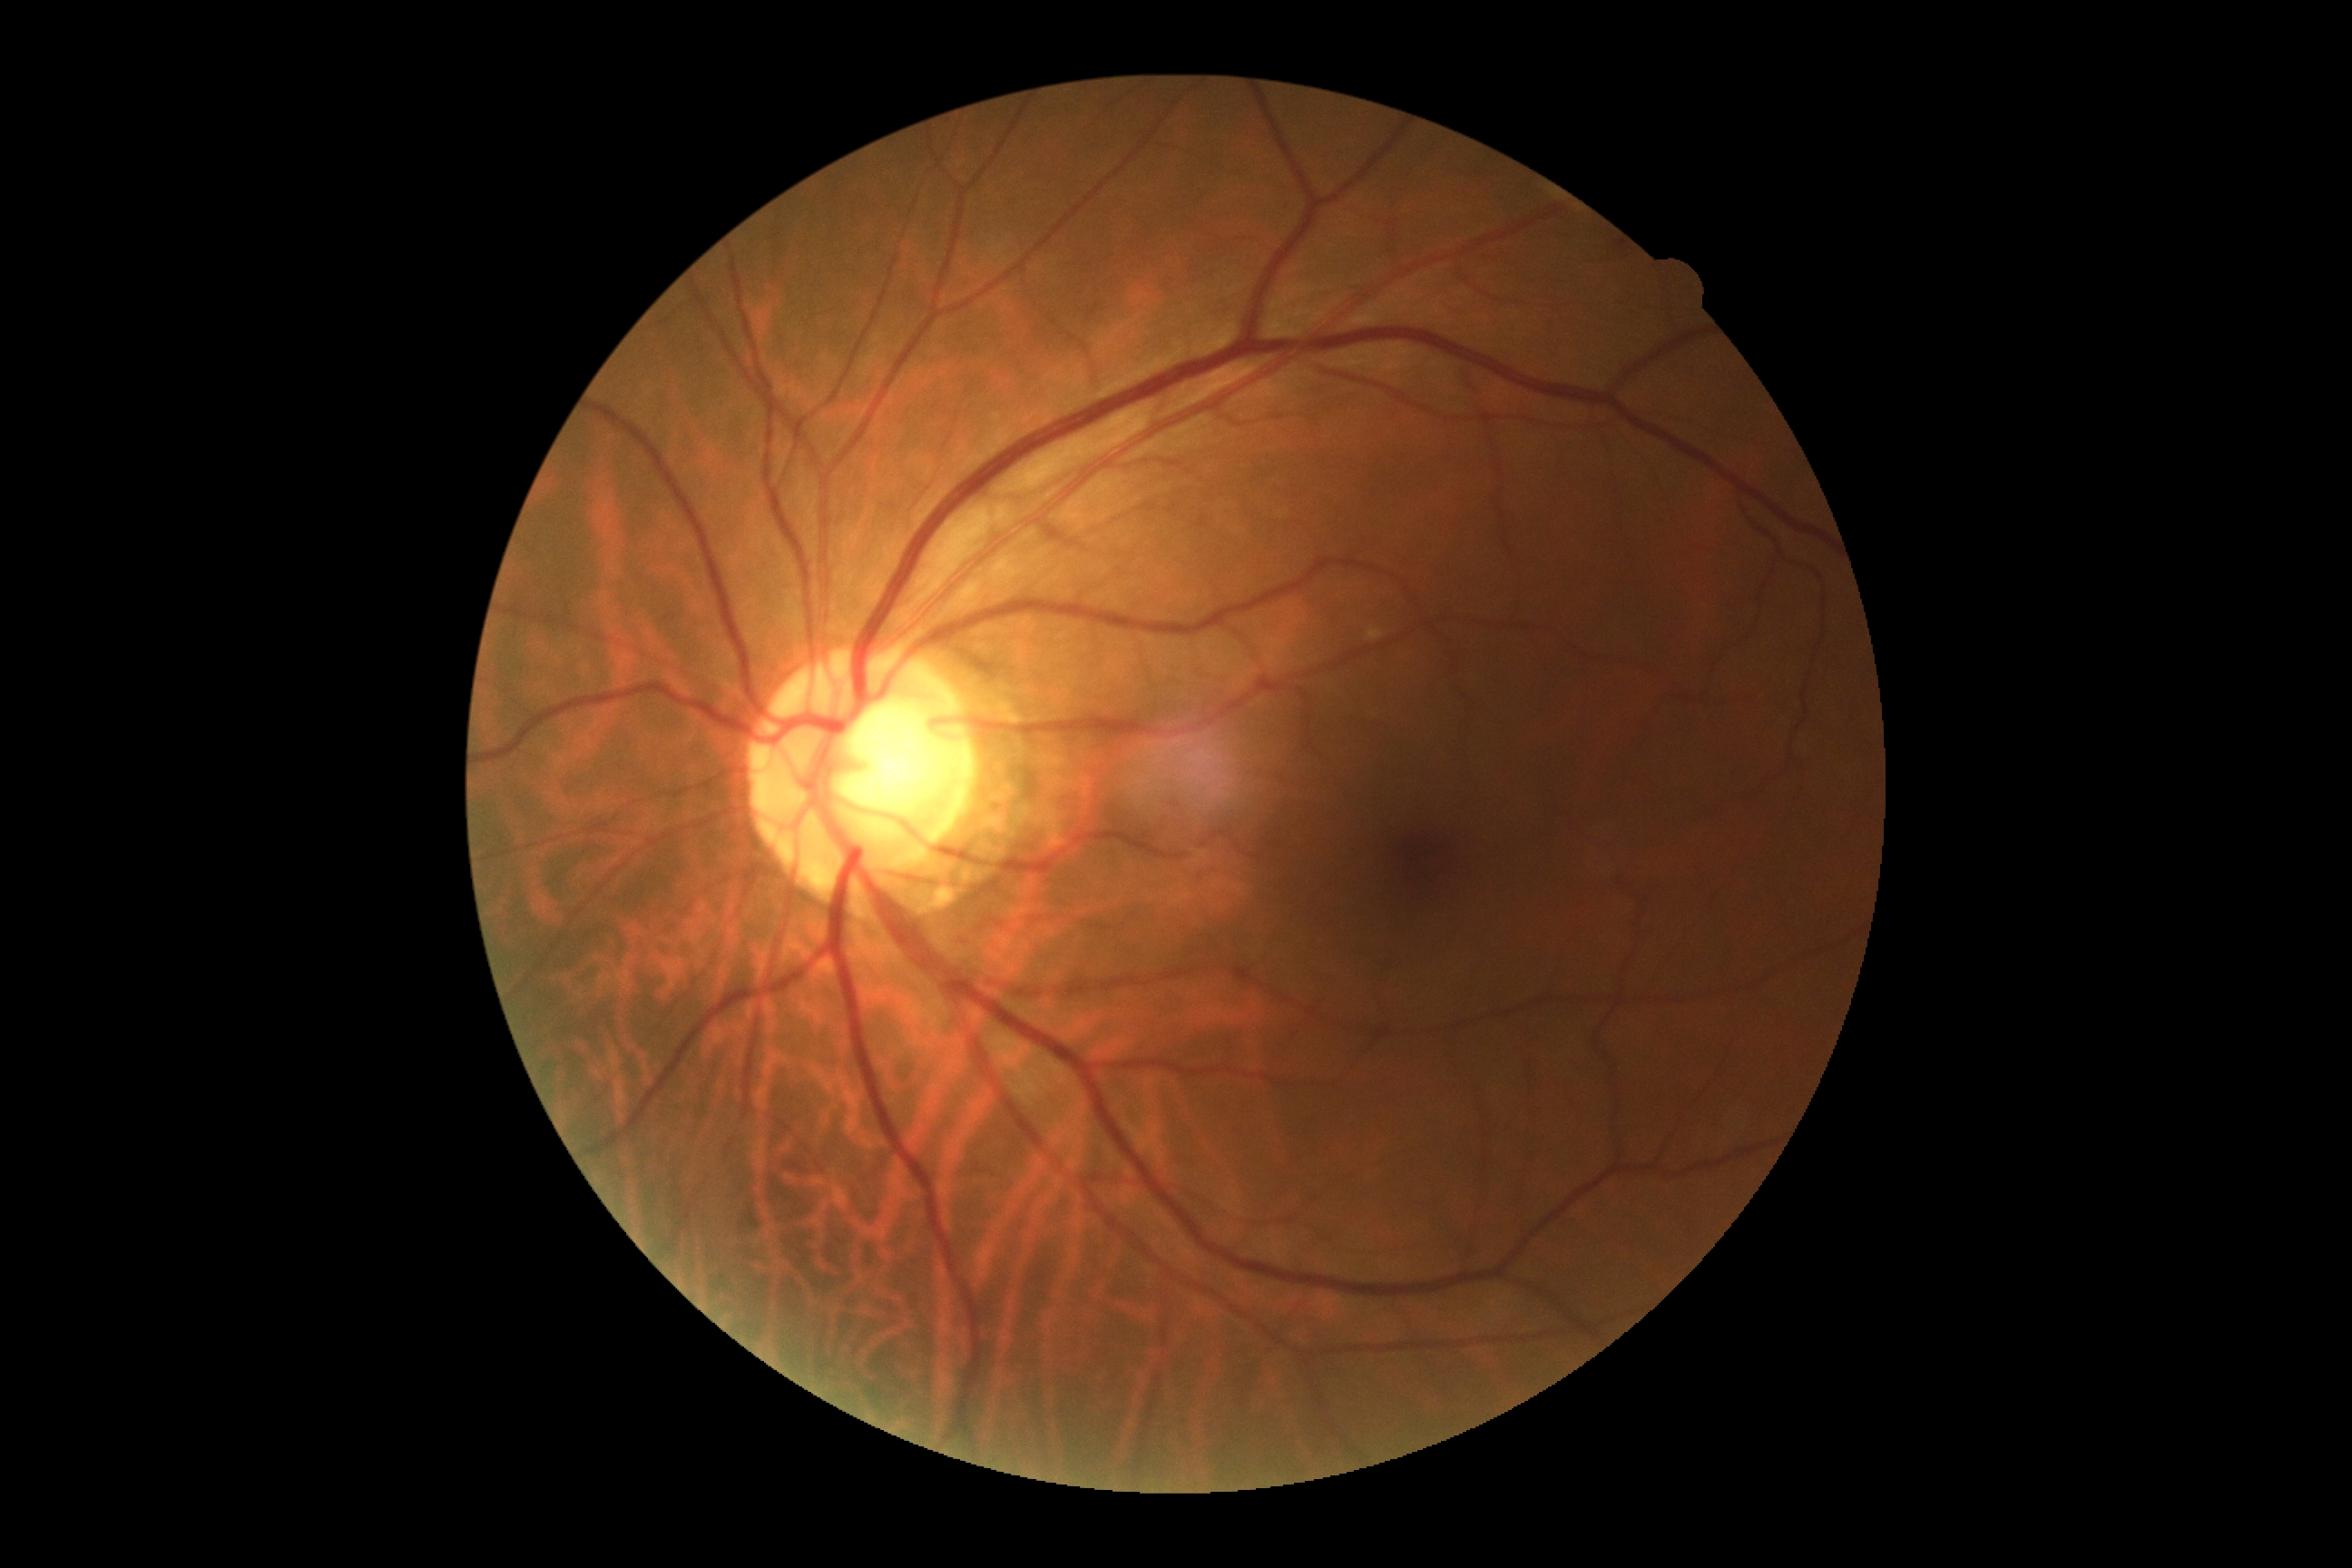 {
  "dr_grade": "no apparent retinopathy (grade 0)"
}